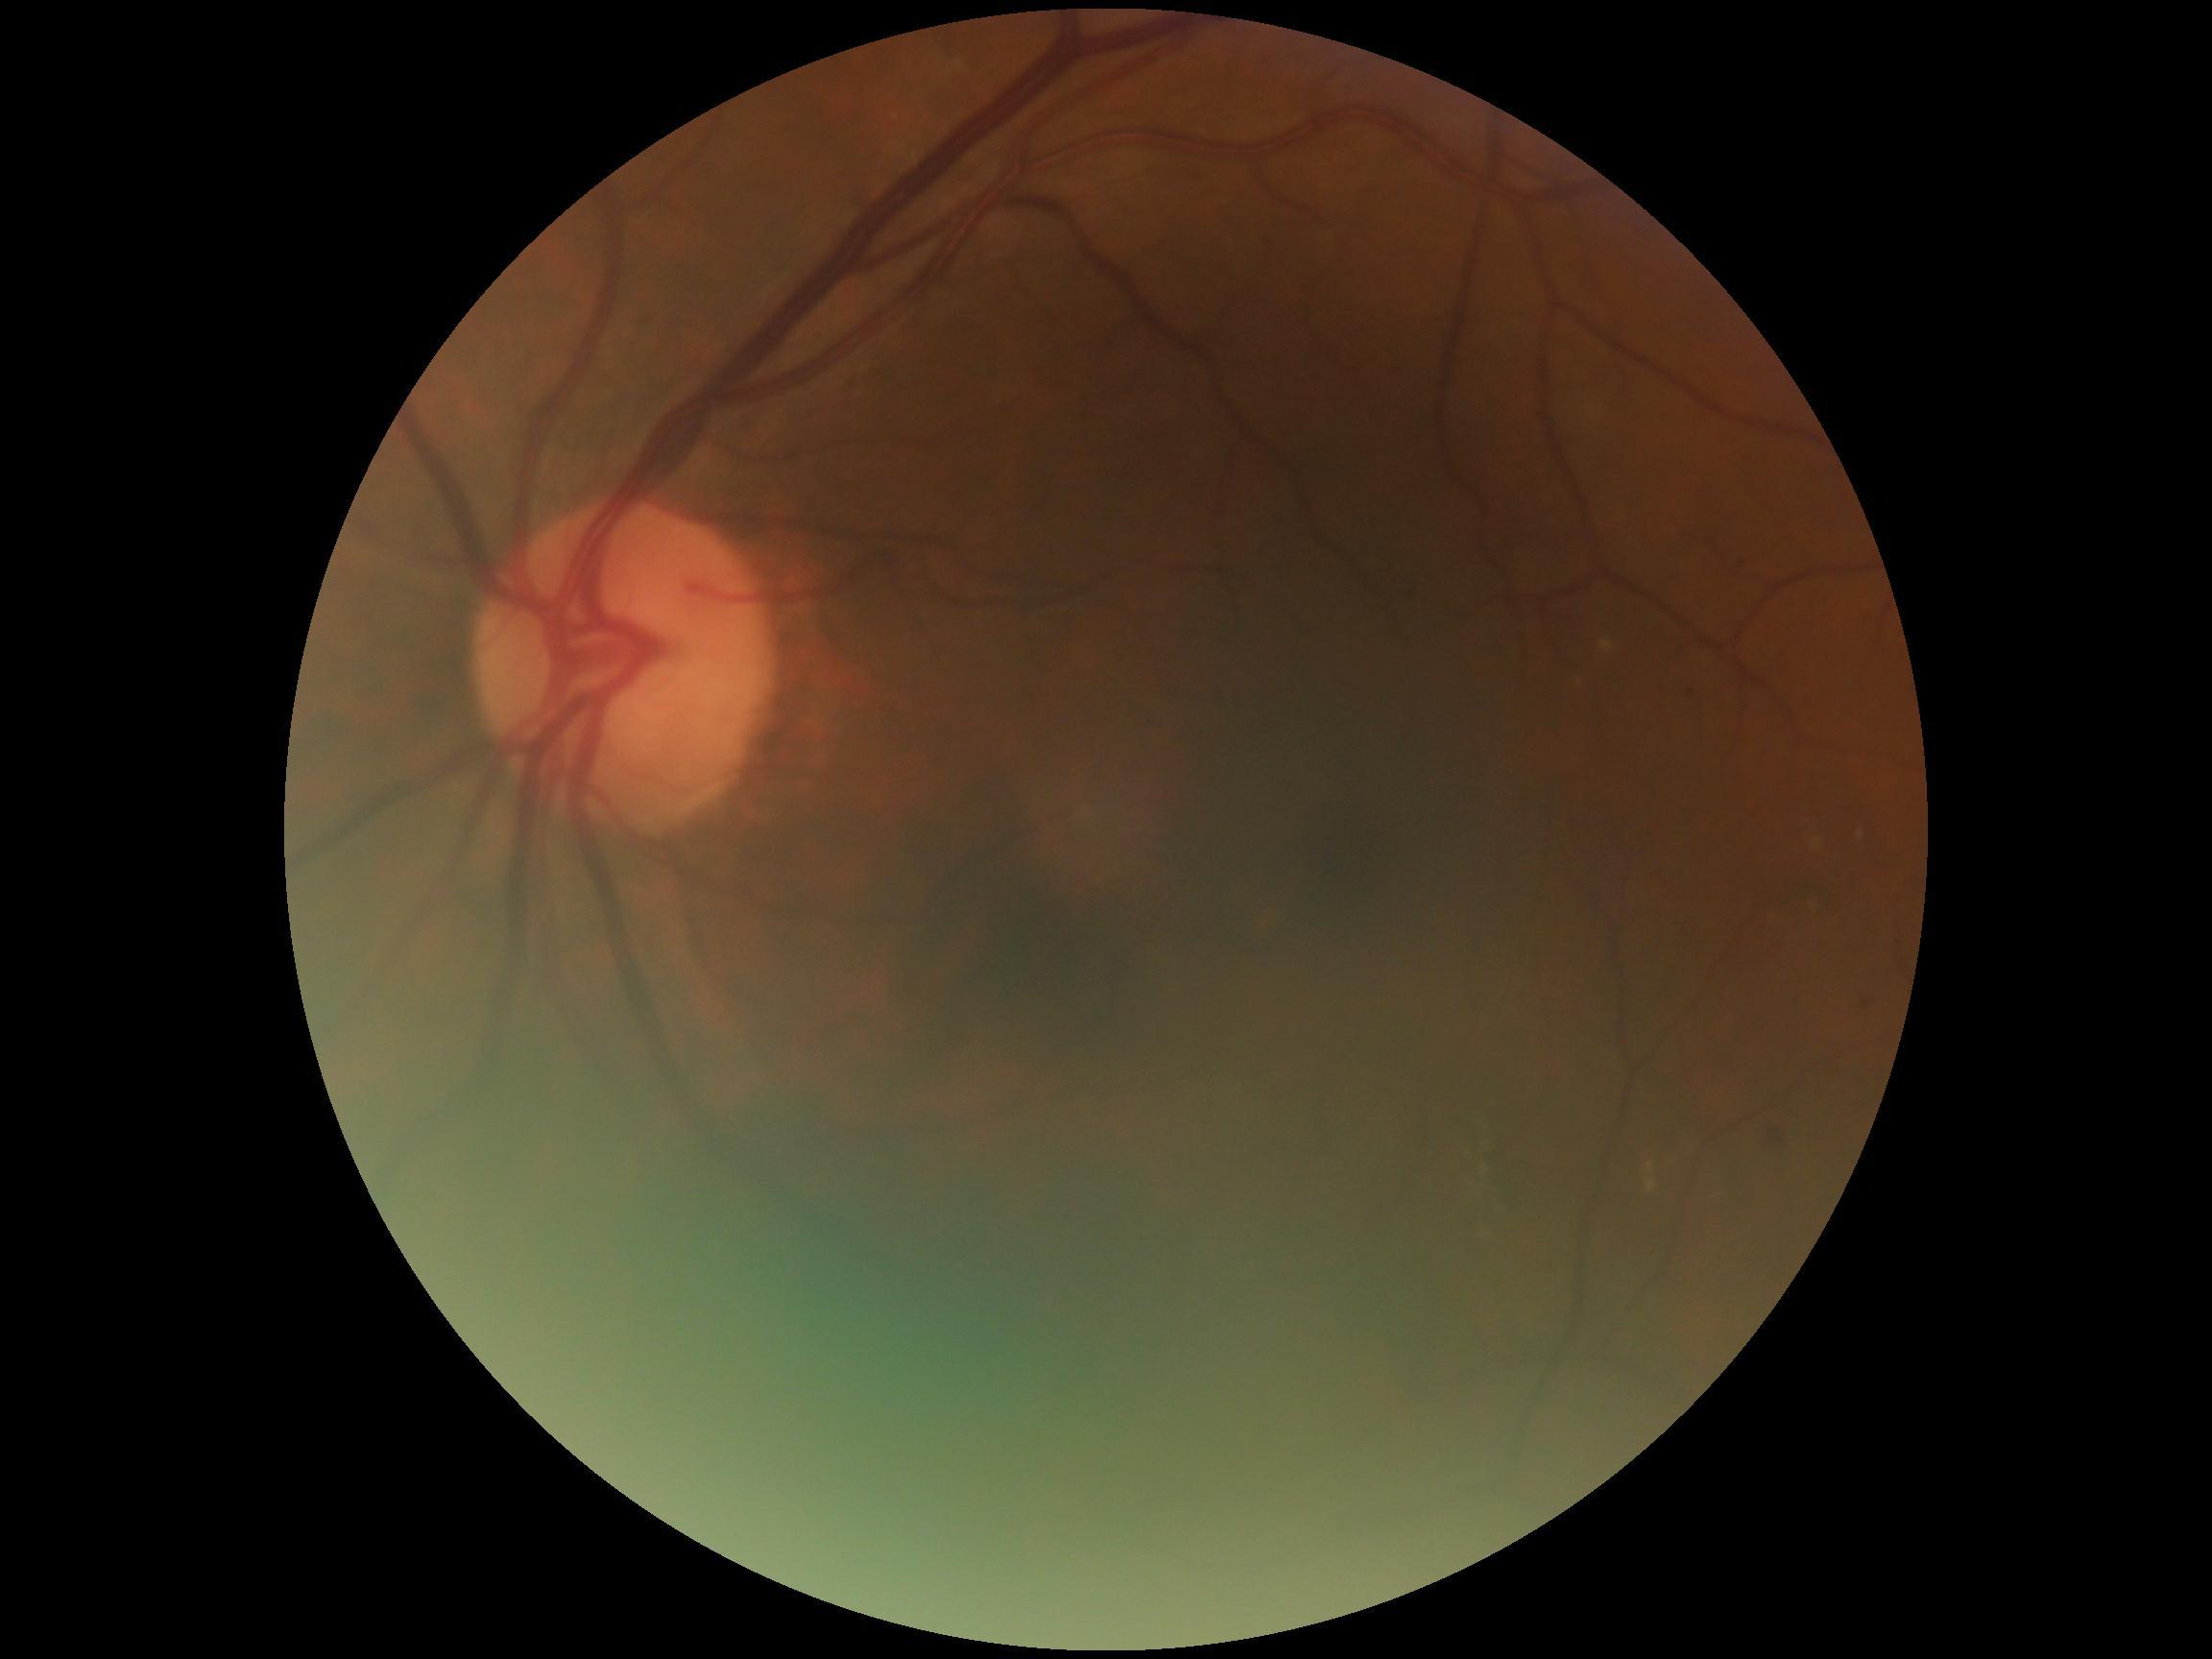 Diabetic retinopathy (DR): moderate NPDR (grade 2) — more than just microaneurysms but less than severe NPDR.